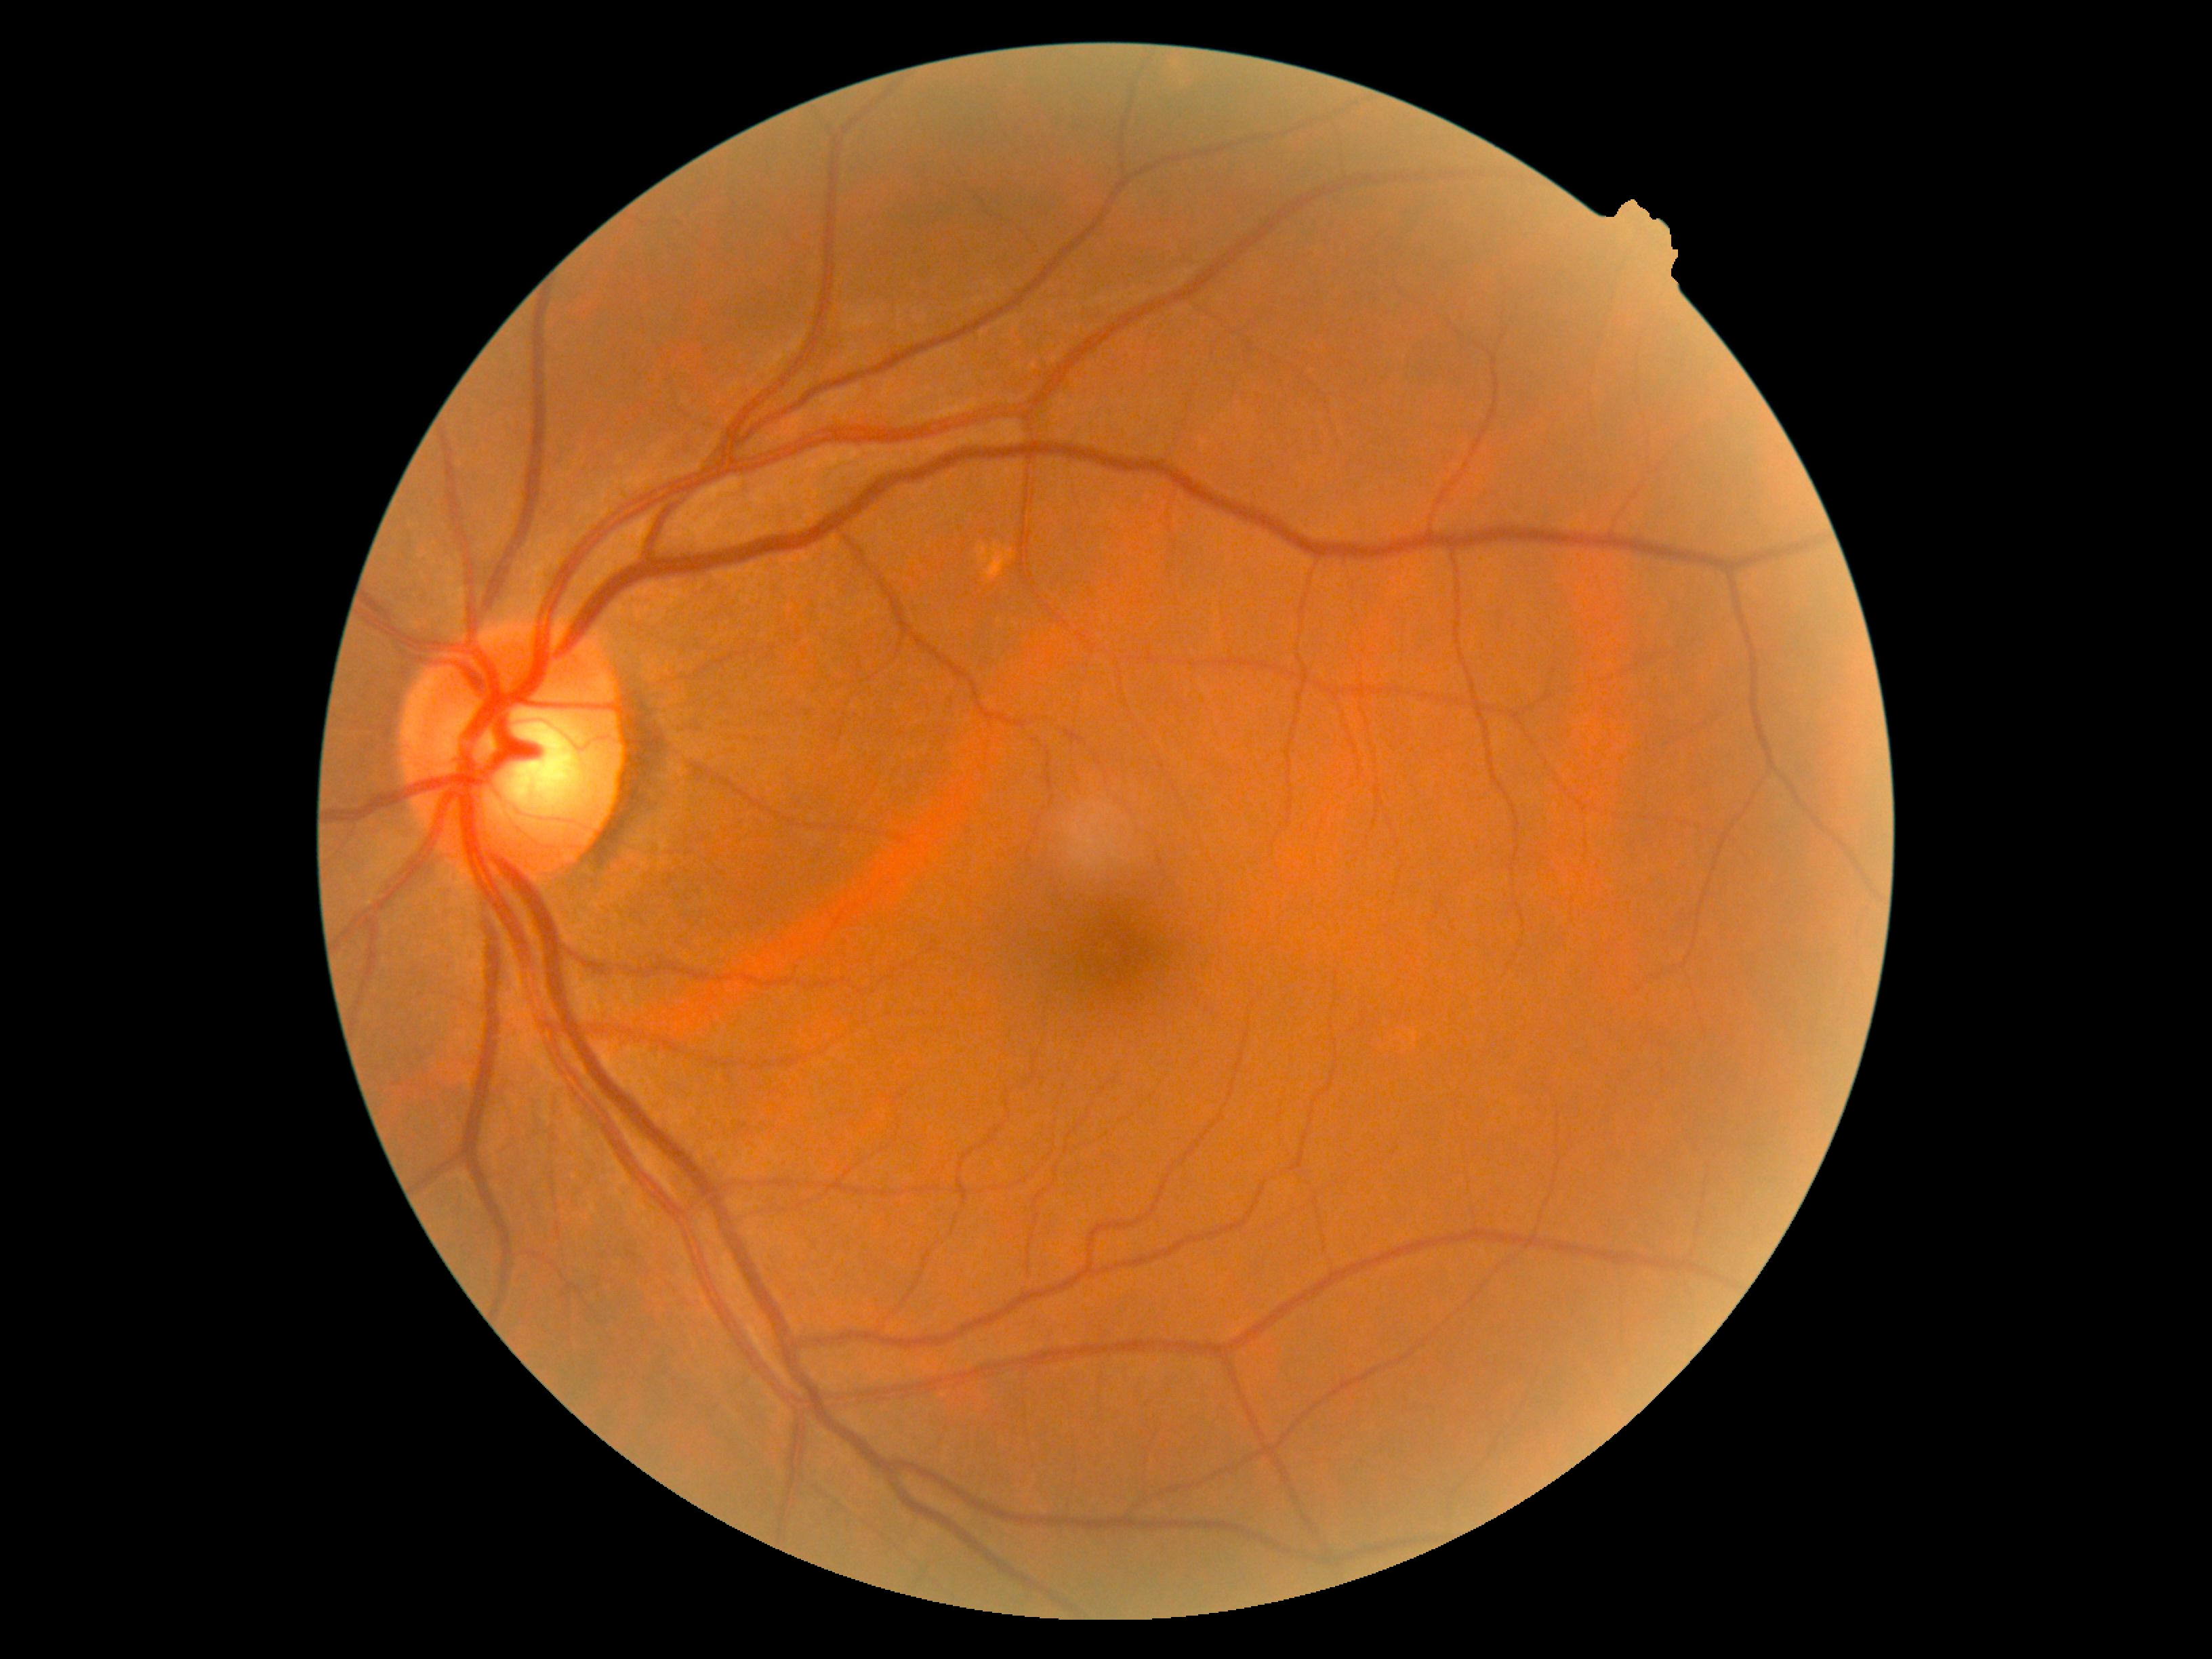 Diabetic retinopathy (DR): grade 0 (no apparent retinopathy).